Optic nerve head crop:
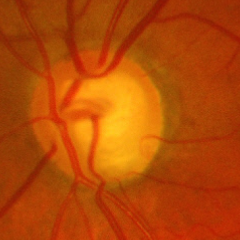

There is evidence of advanced glaucoma.